Diabetic retinopathy graded by the modified Davis classification, without pupil dilation, 45 degree fundus photograph, color fundus image.
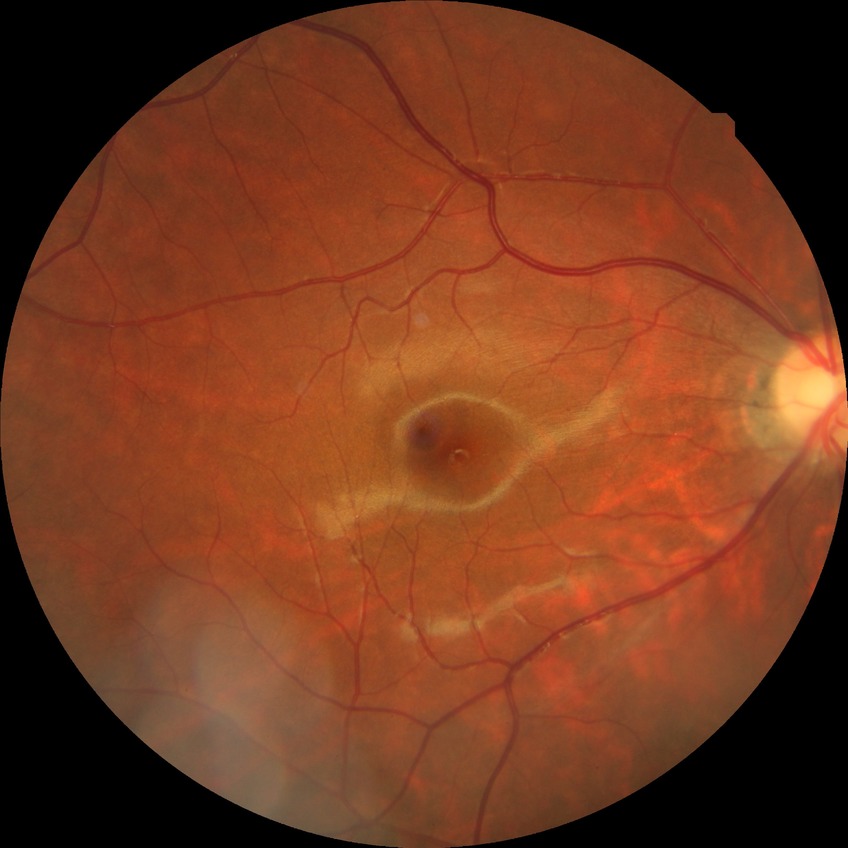
Annotations:
* retinopathy grade: no diabetic retinopathy